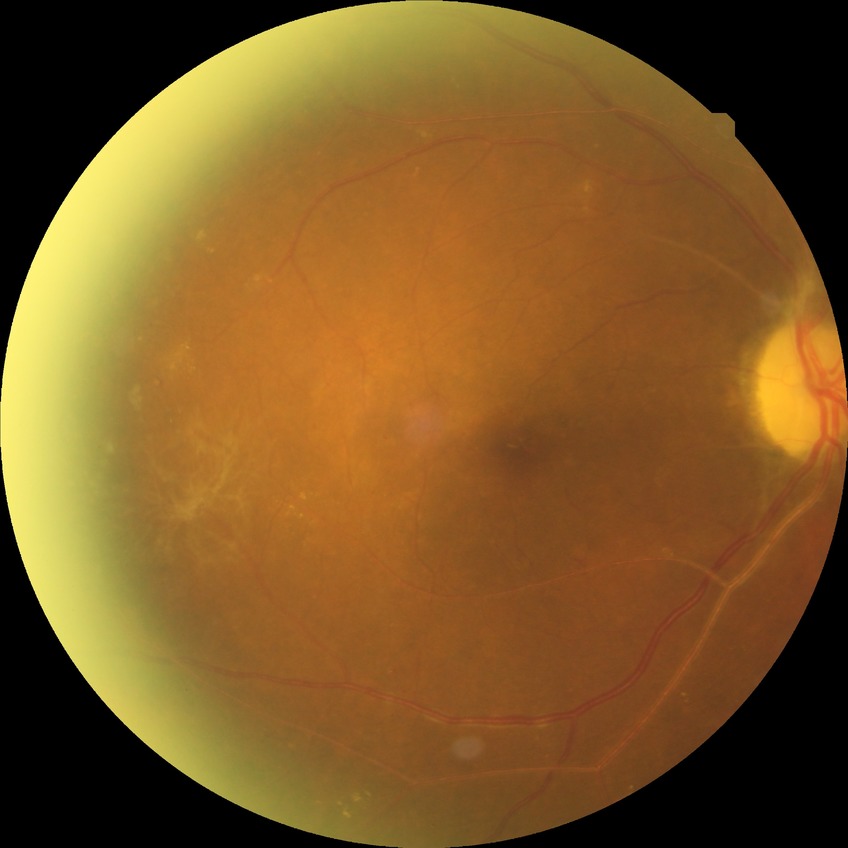

diabetic retinopathy (DR): proliferative diabetic retinopathy (PDR).